Fundus photo · 1659x2212px.
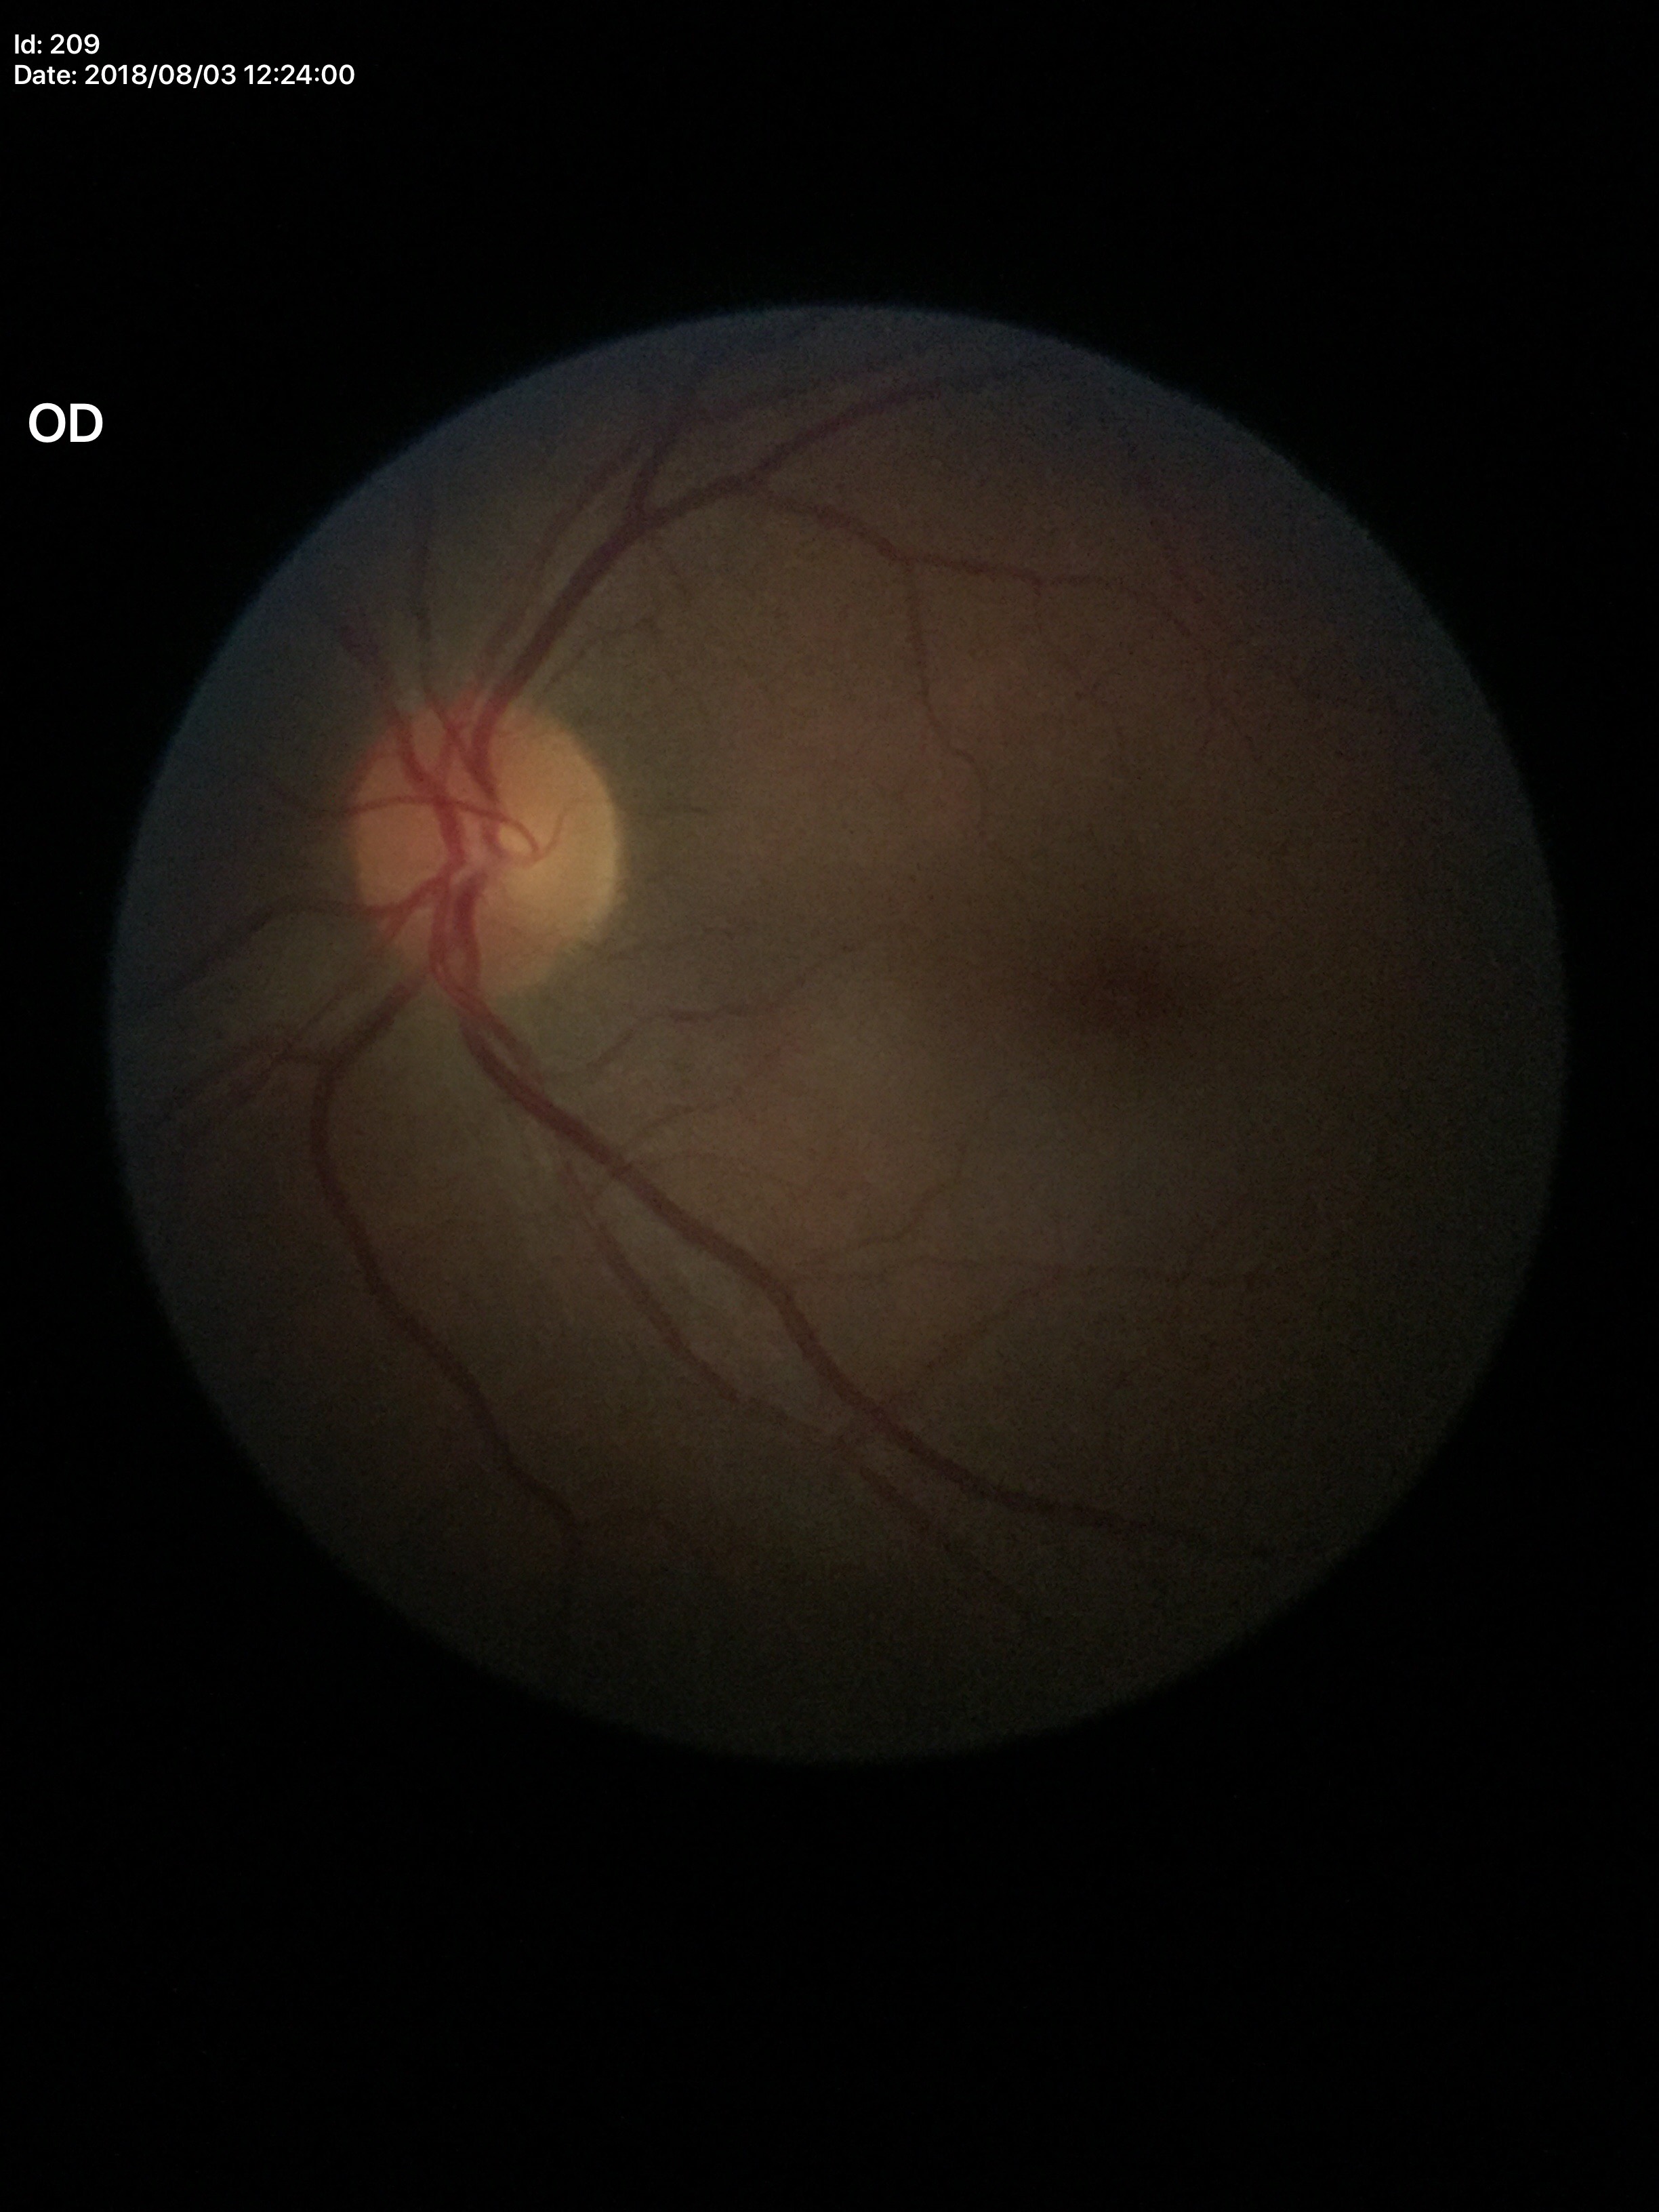

Glaucoma decision: no suspicious findings (unanimous normal call). Vertical C/D ratio of 0.42.